Modified Davis classification · posterior pole photograph — 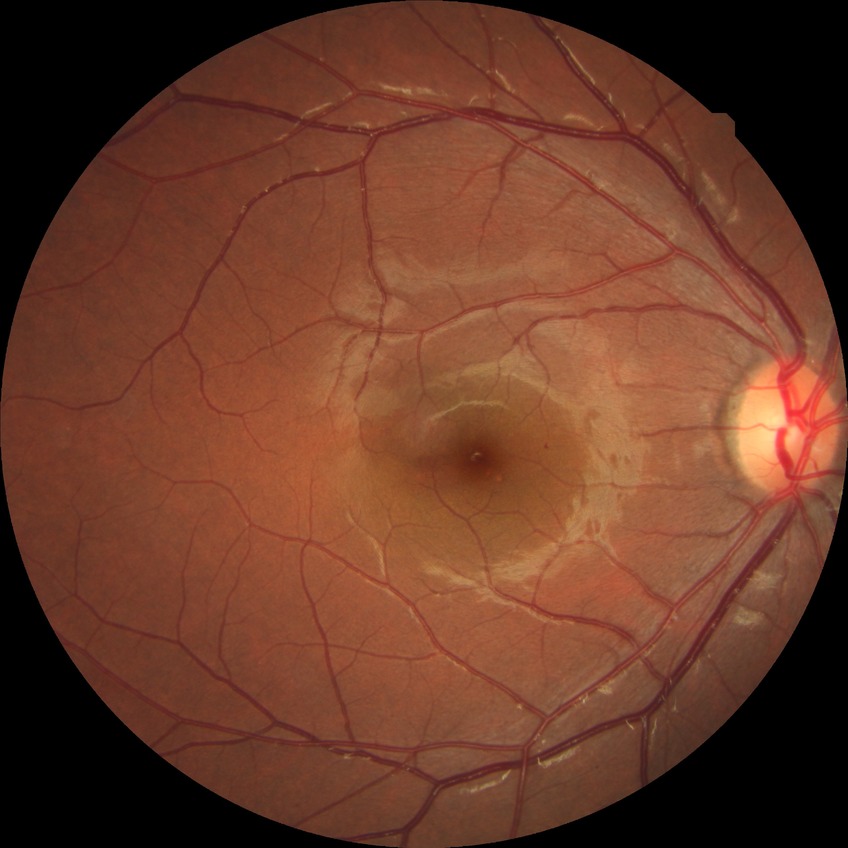

retinopathy stage: no diabetic retinopathy.